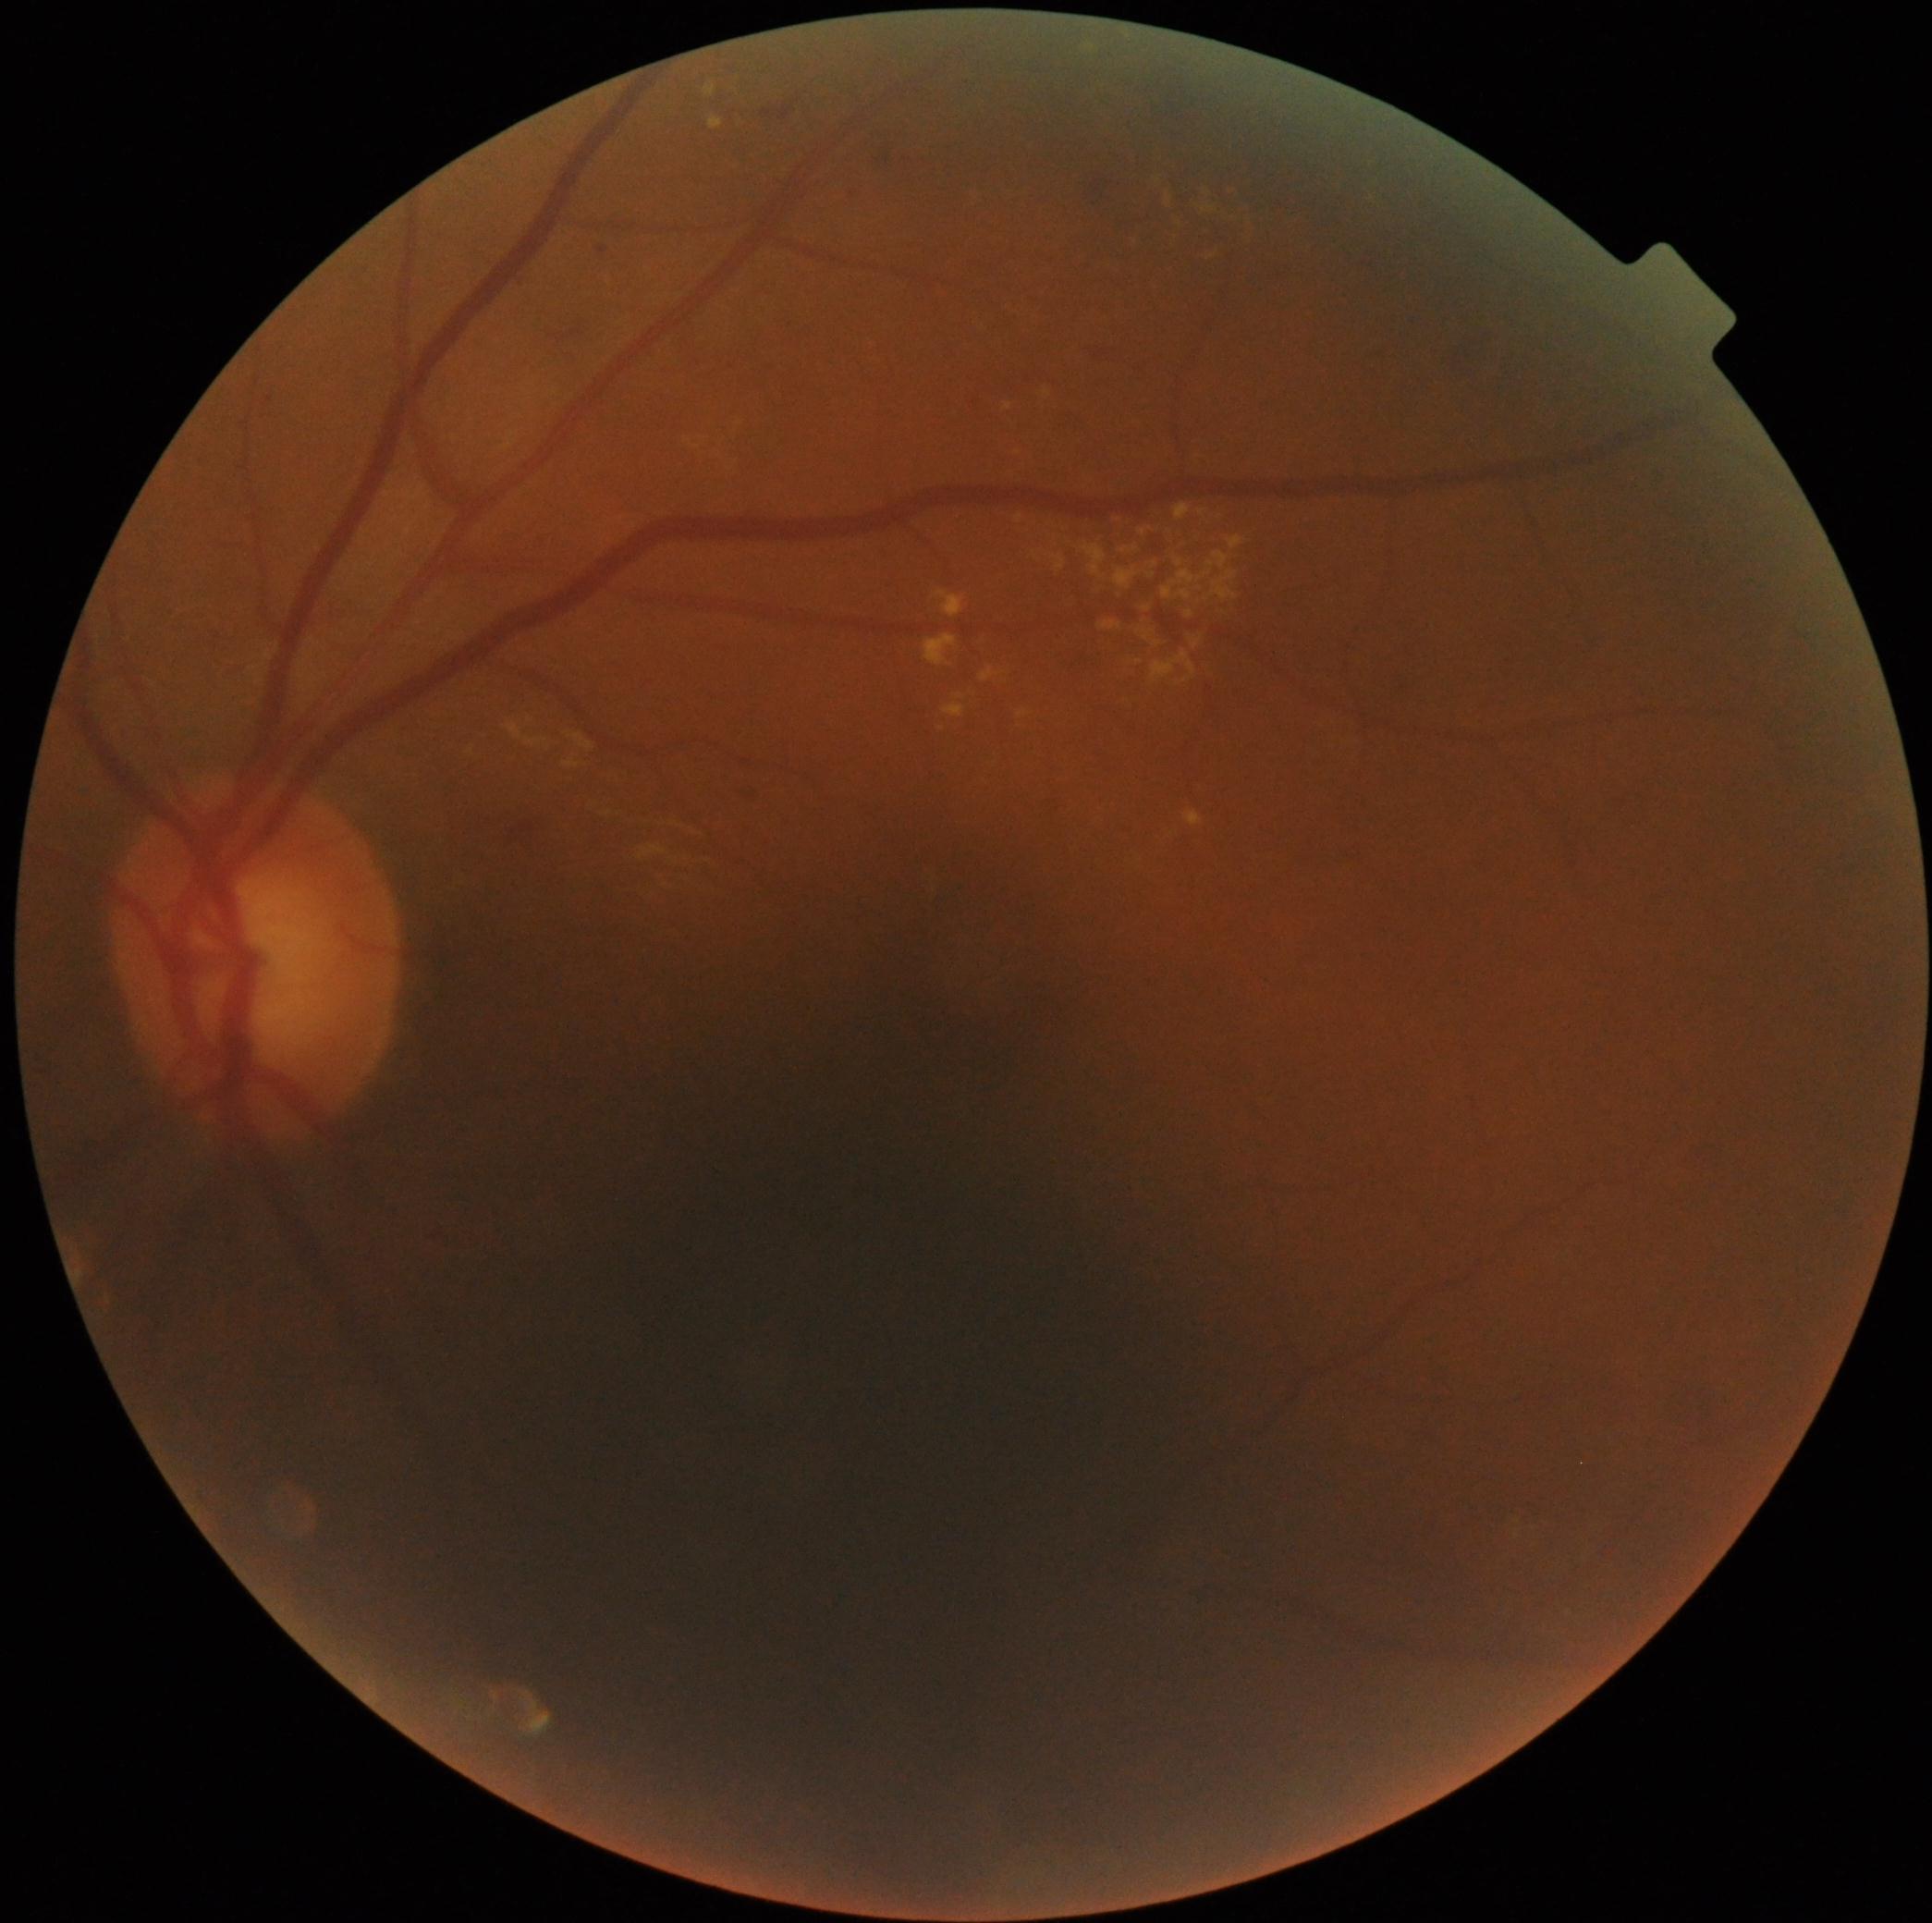 diabetic retinopathy (DR) = grade 2 (moderate NPDR)